Wide-field fundus photograph from neonatal ROP screening.
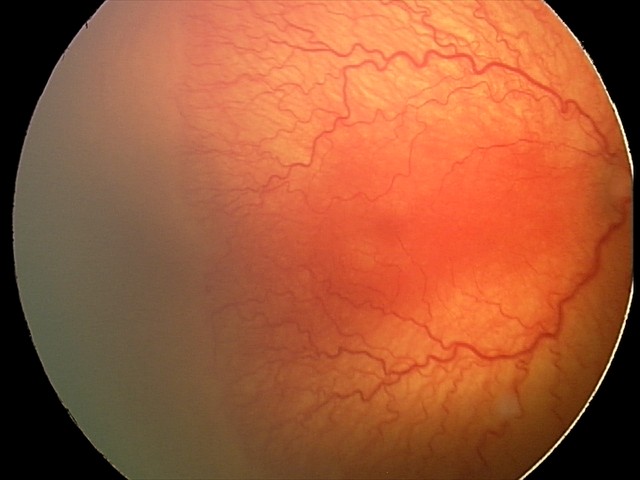
Impression = aggressive retinopathy of prematurity; plus form = present.